Infant wide-field retinal image · 640 by 480 pixels — 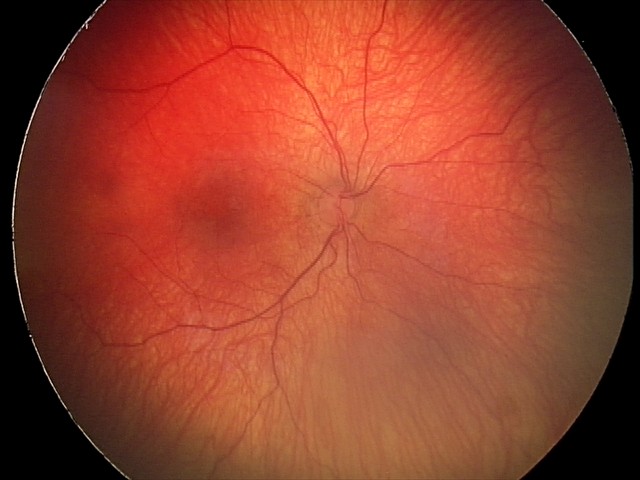 Screening series with status post ROP.
No plus disease.